45° FOV · diabetic retinopathy graded by the modified Davis classification — 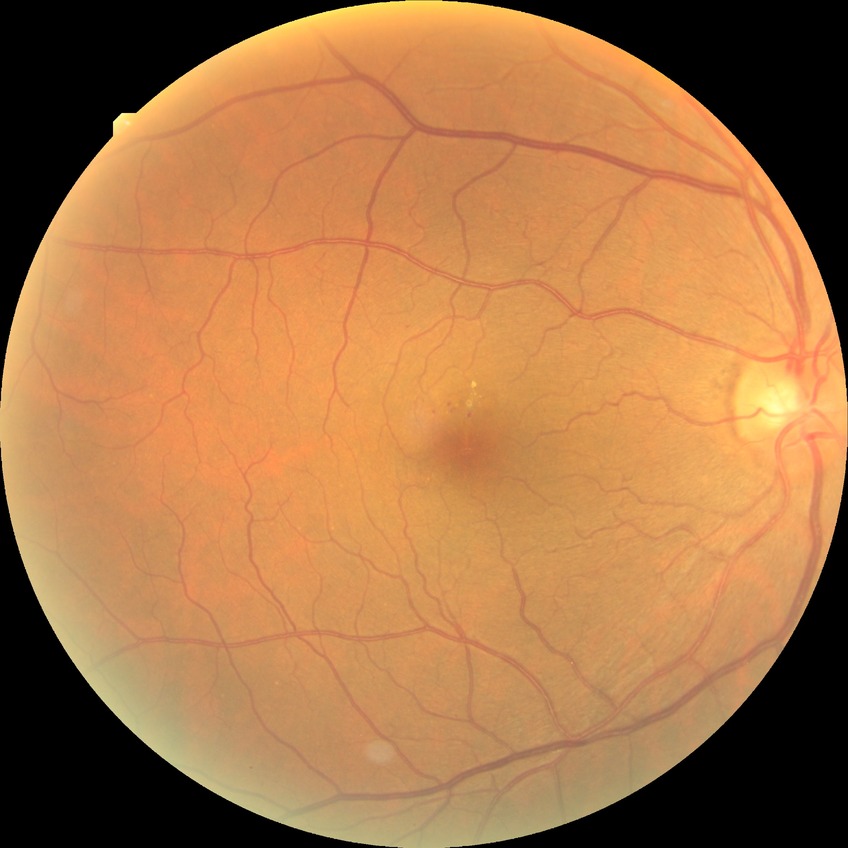

The retinopathy is classified as non-proliferative diabetic retinopathy.
Diabetic retinopathy grade: simple diabetic retinopathy.